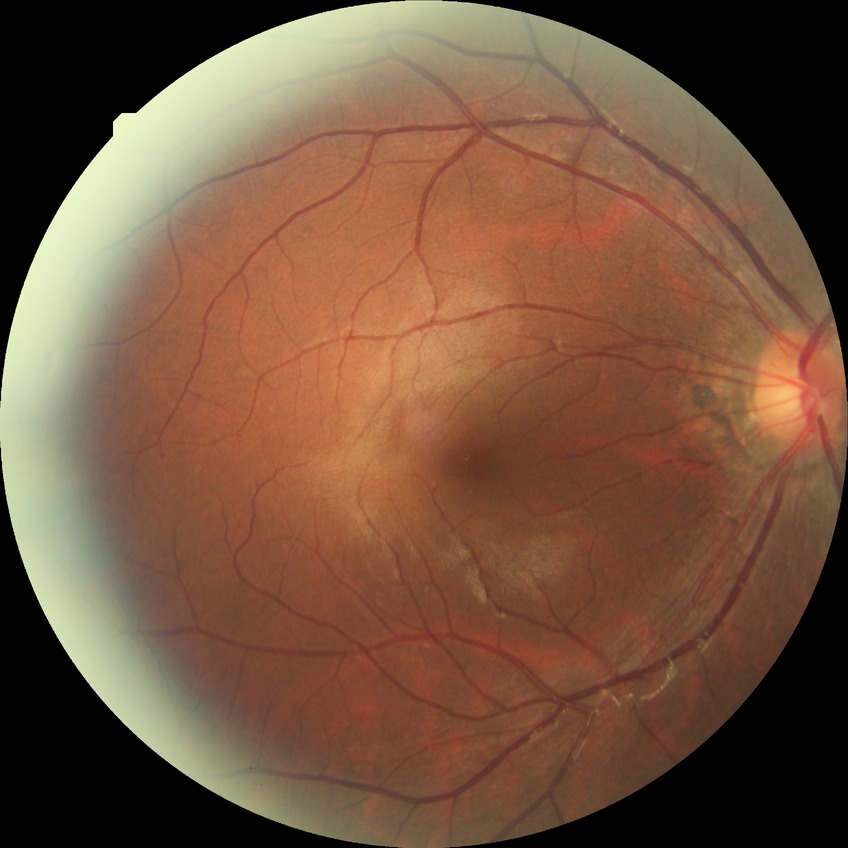
{
  "davis_grade": "NDR (no diabetic retinopathy)"
}